DR severity per modified Davis staging, acquired with a NIDEK AFC-230 — 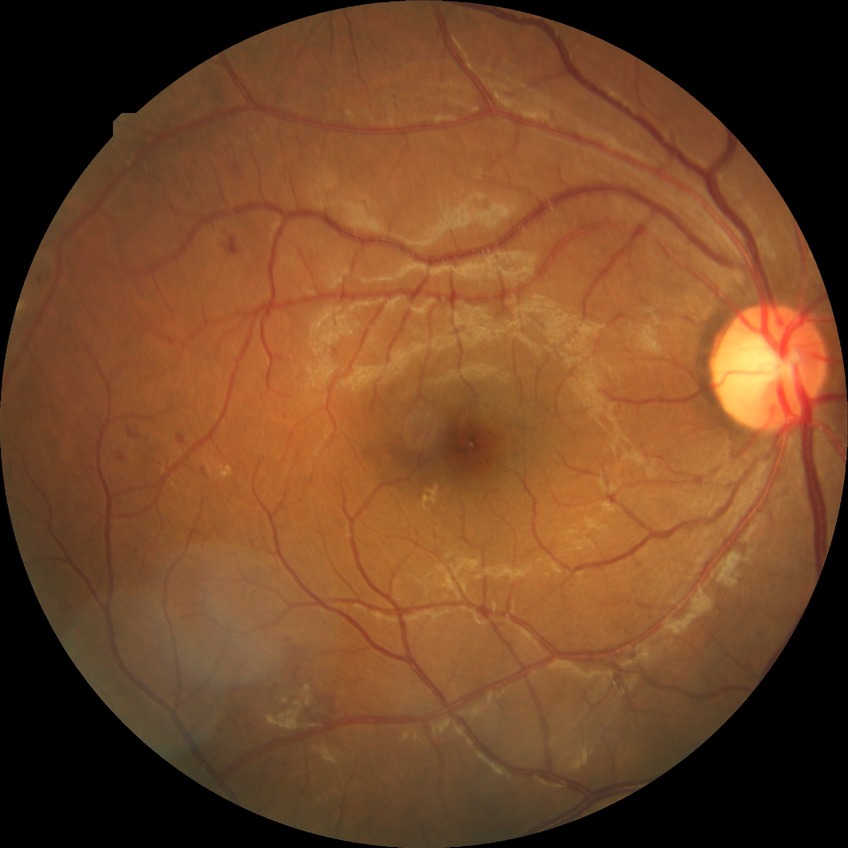

Assessment:
• retinopathy grade — simple diabetic retinopathy